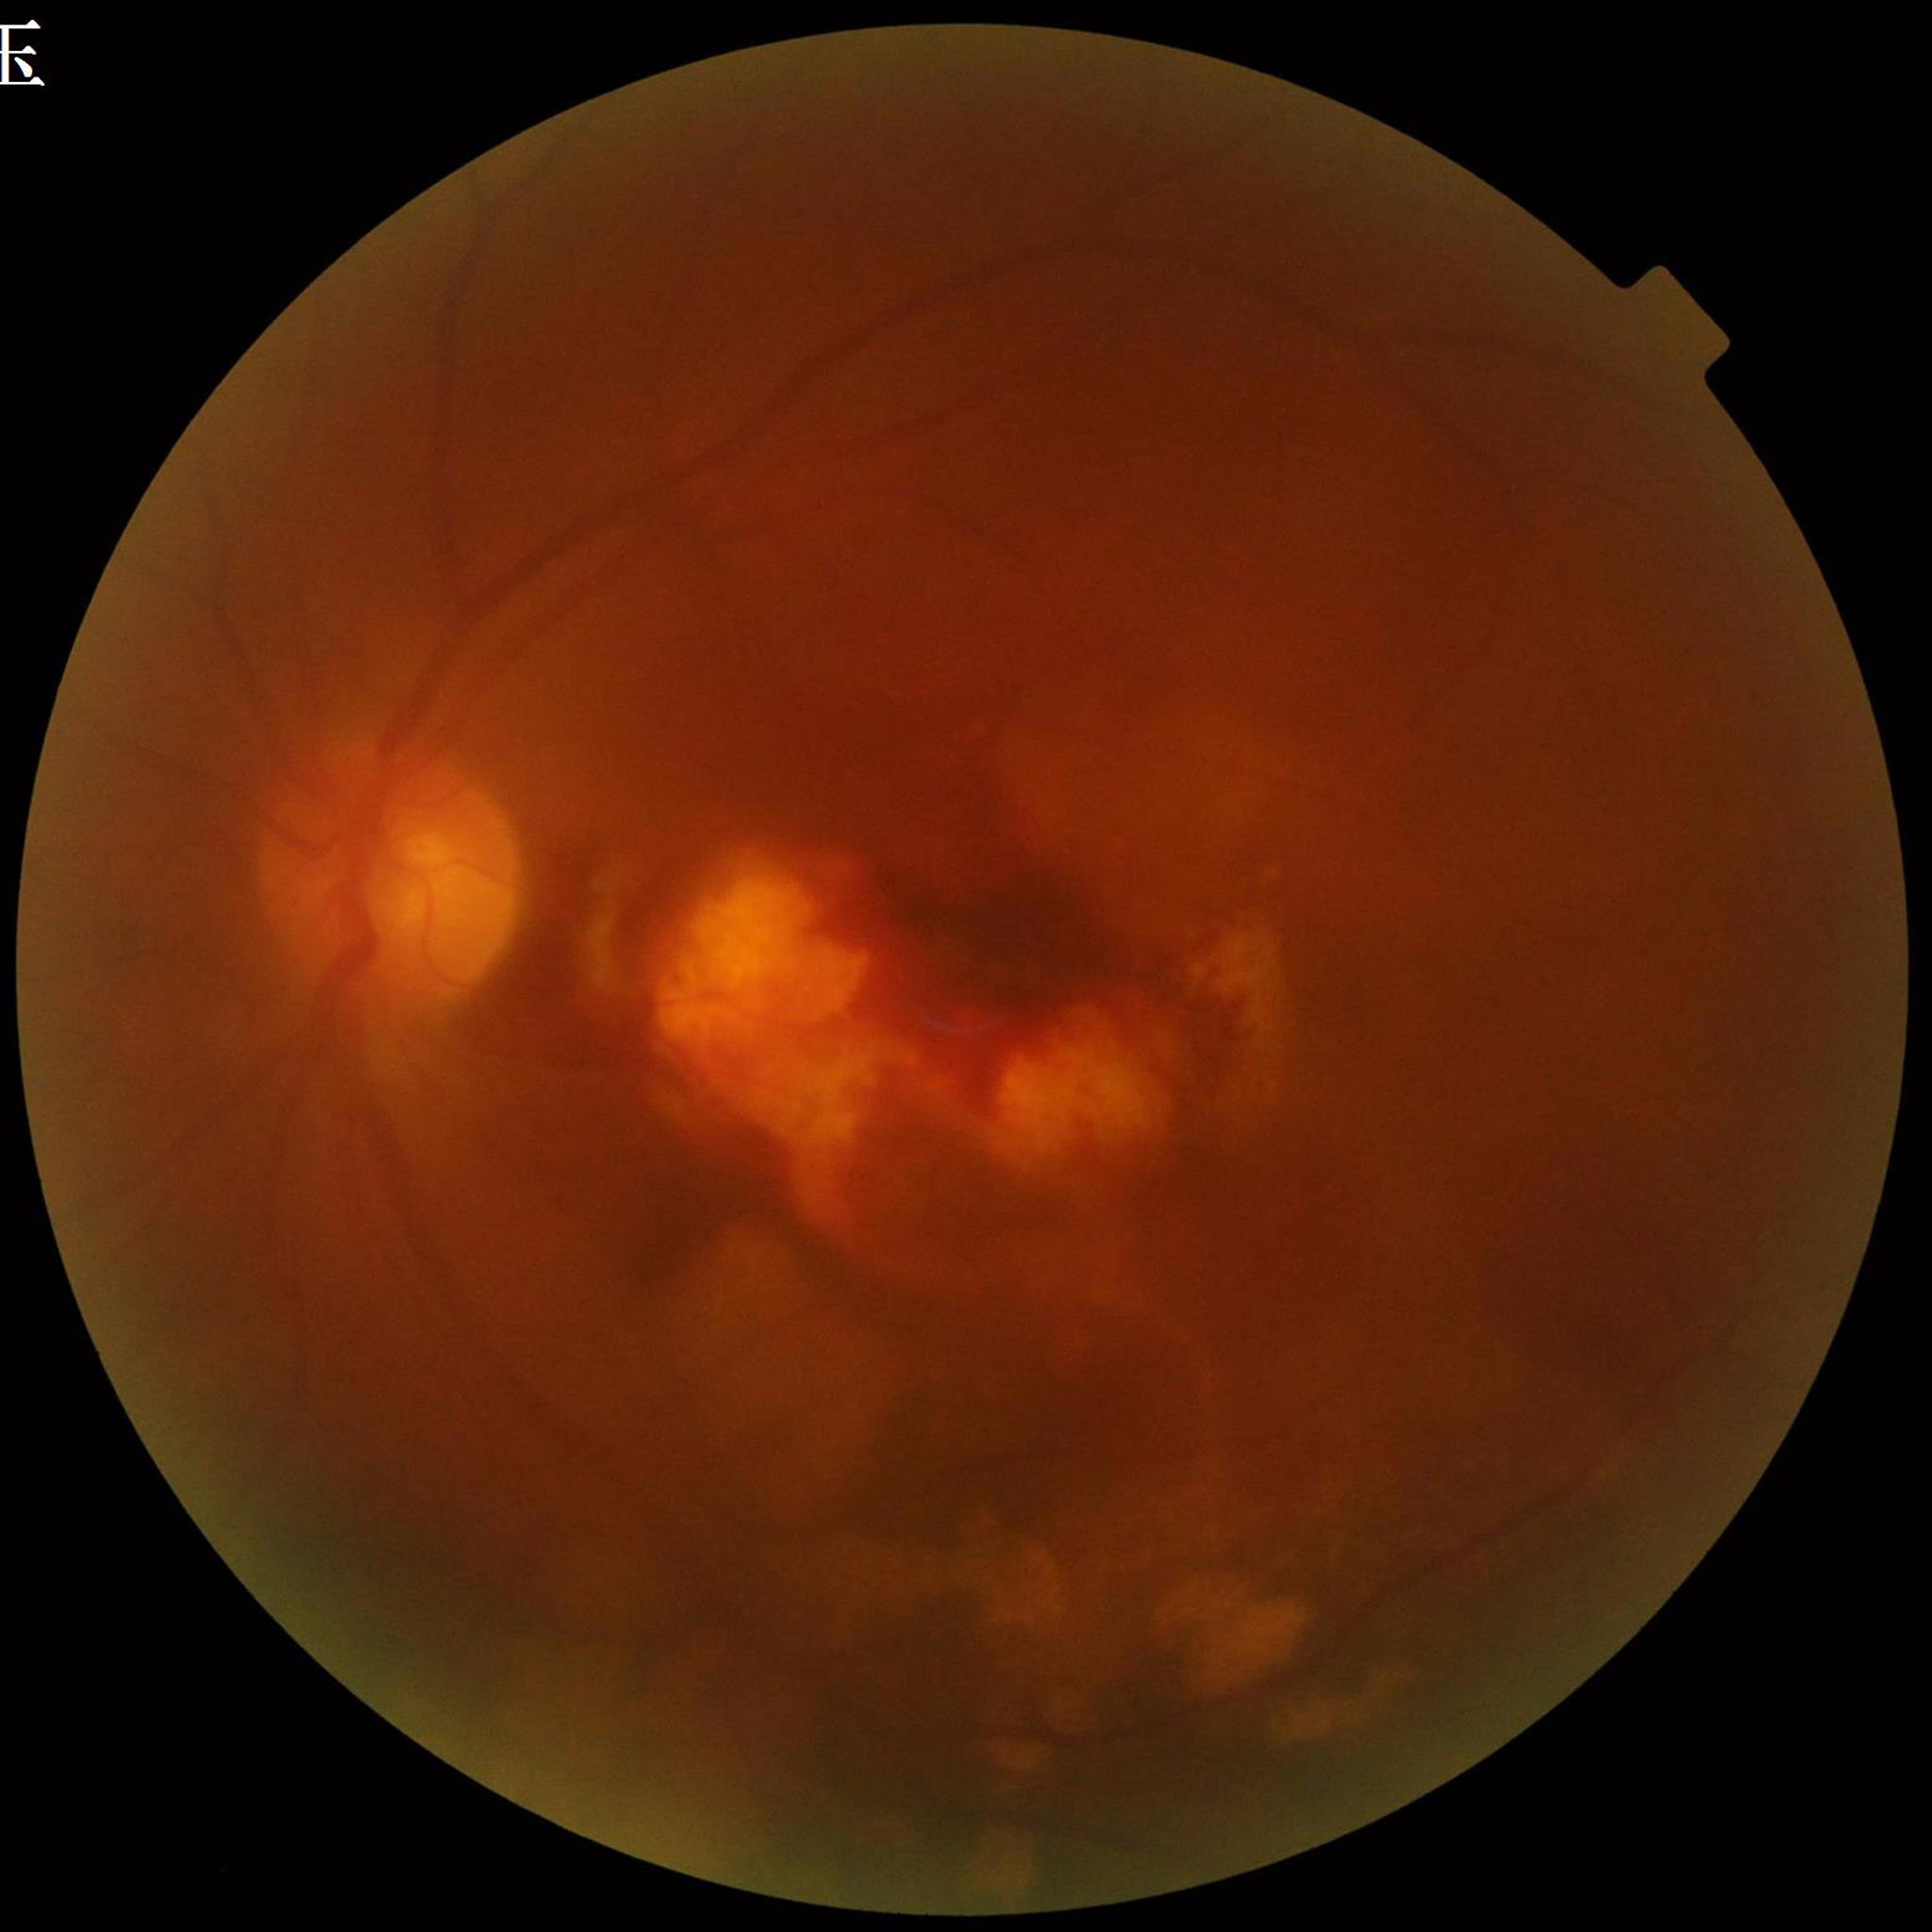
{
  "image_quality": "suboptimal — illumination/color distortion, blur",
  "diagnosis": "AMD"
}